Acquired with a NIDEK AFC-230 · nonmydriatic — 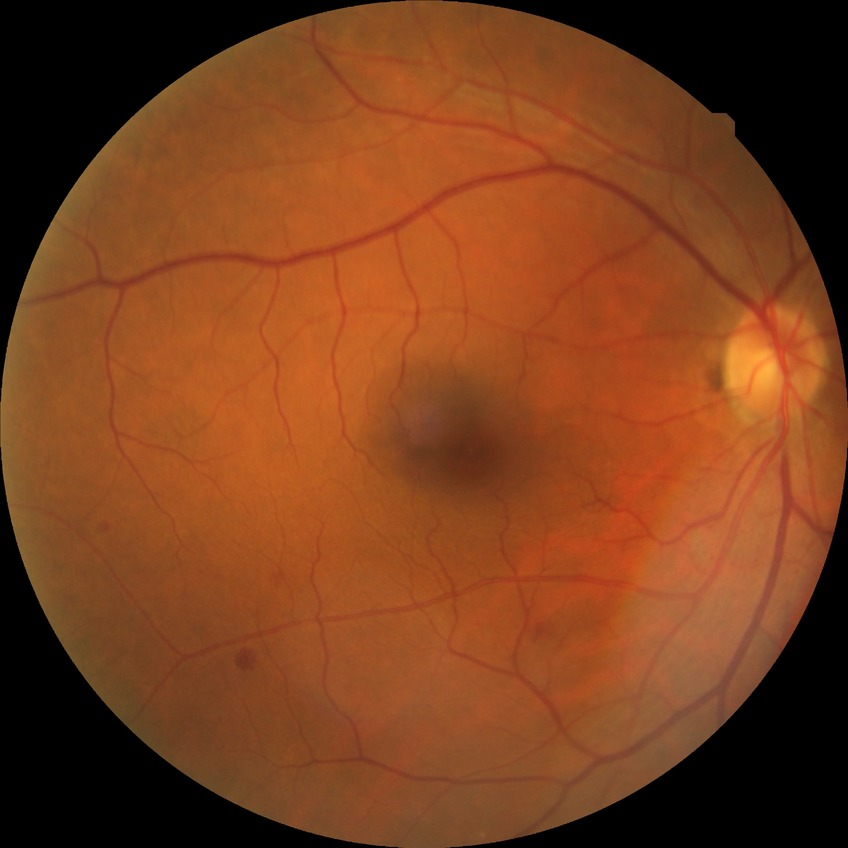

diabetic retinopathy (DR)@SDR (simple diabetic retinopathy).